Image size 1960x1897 — 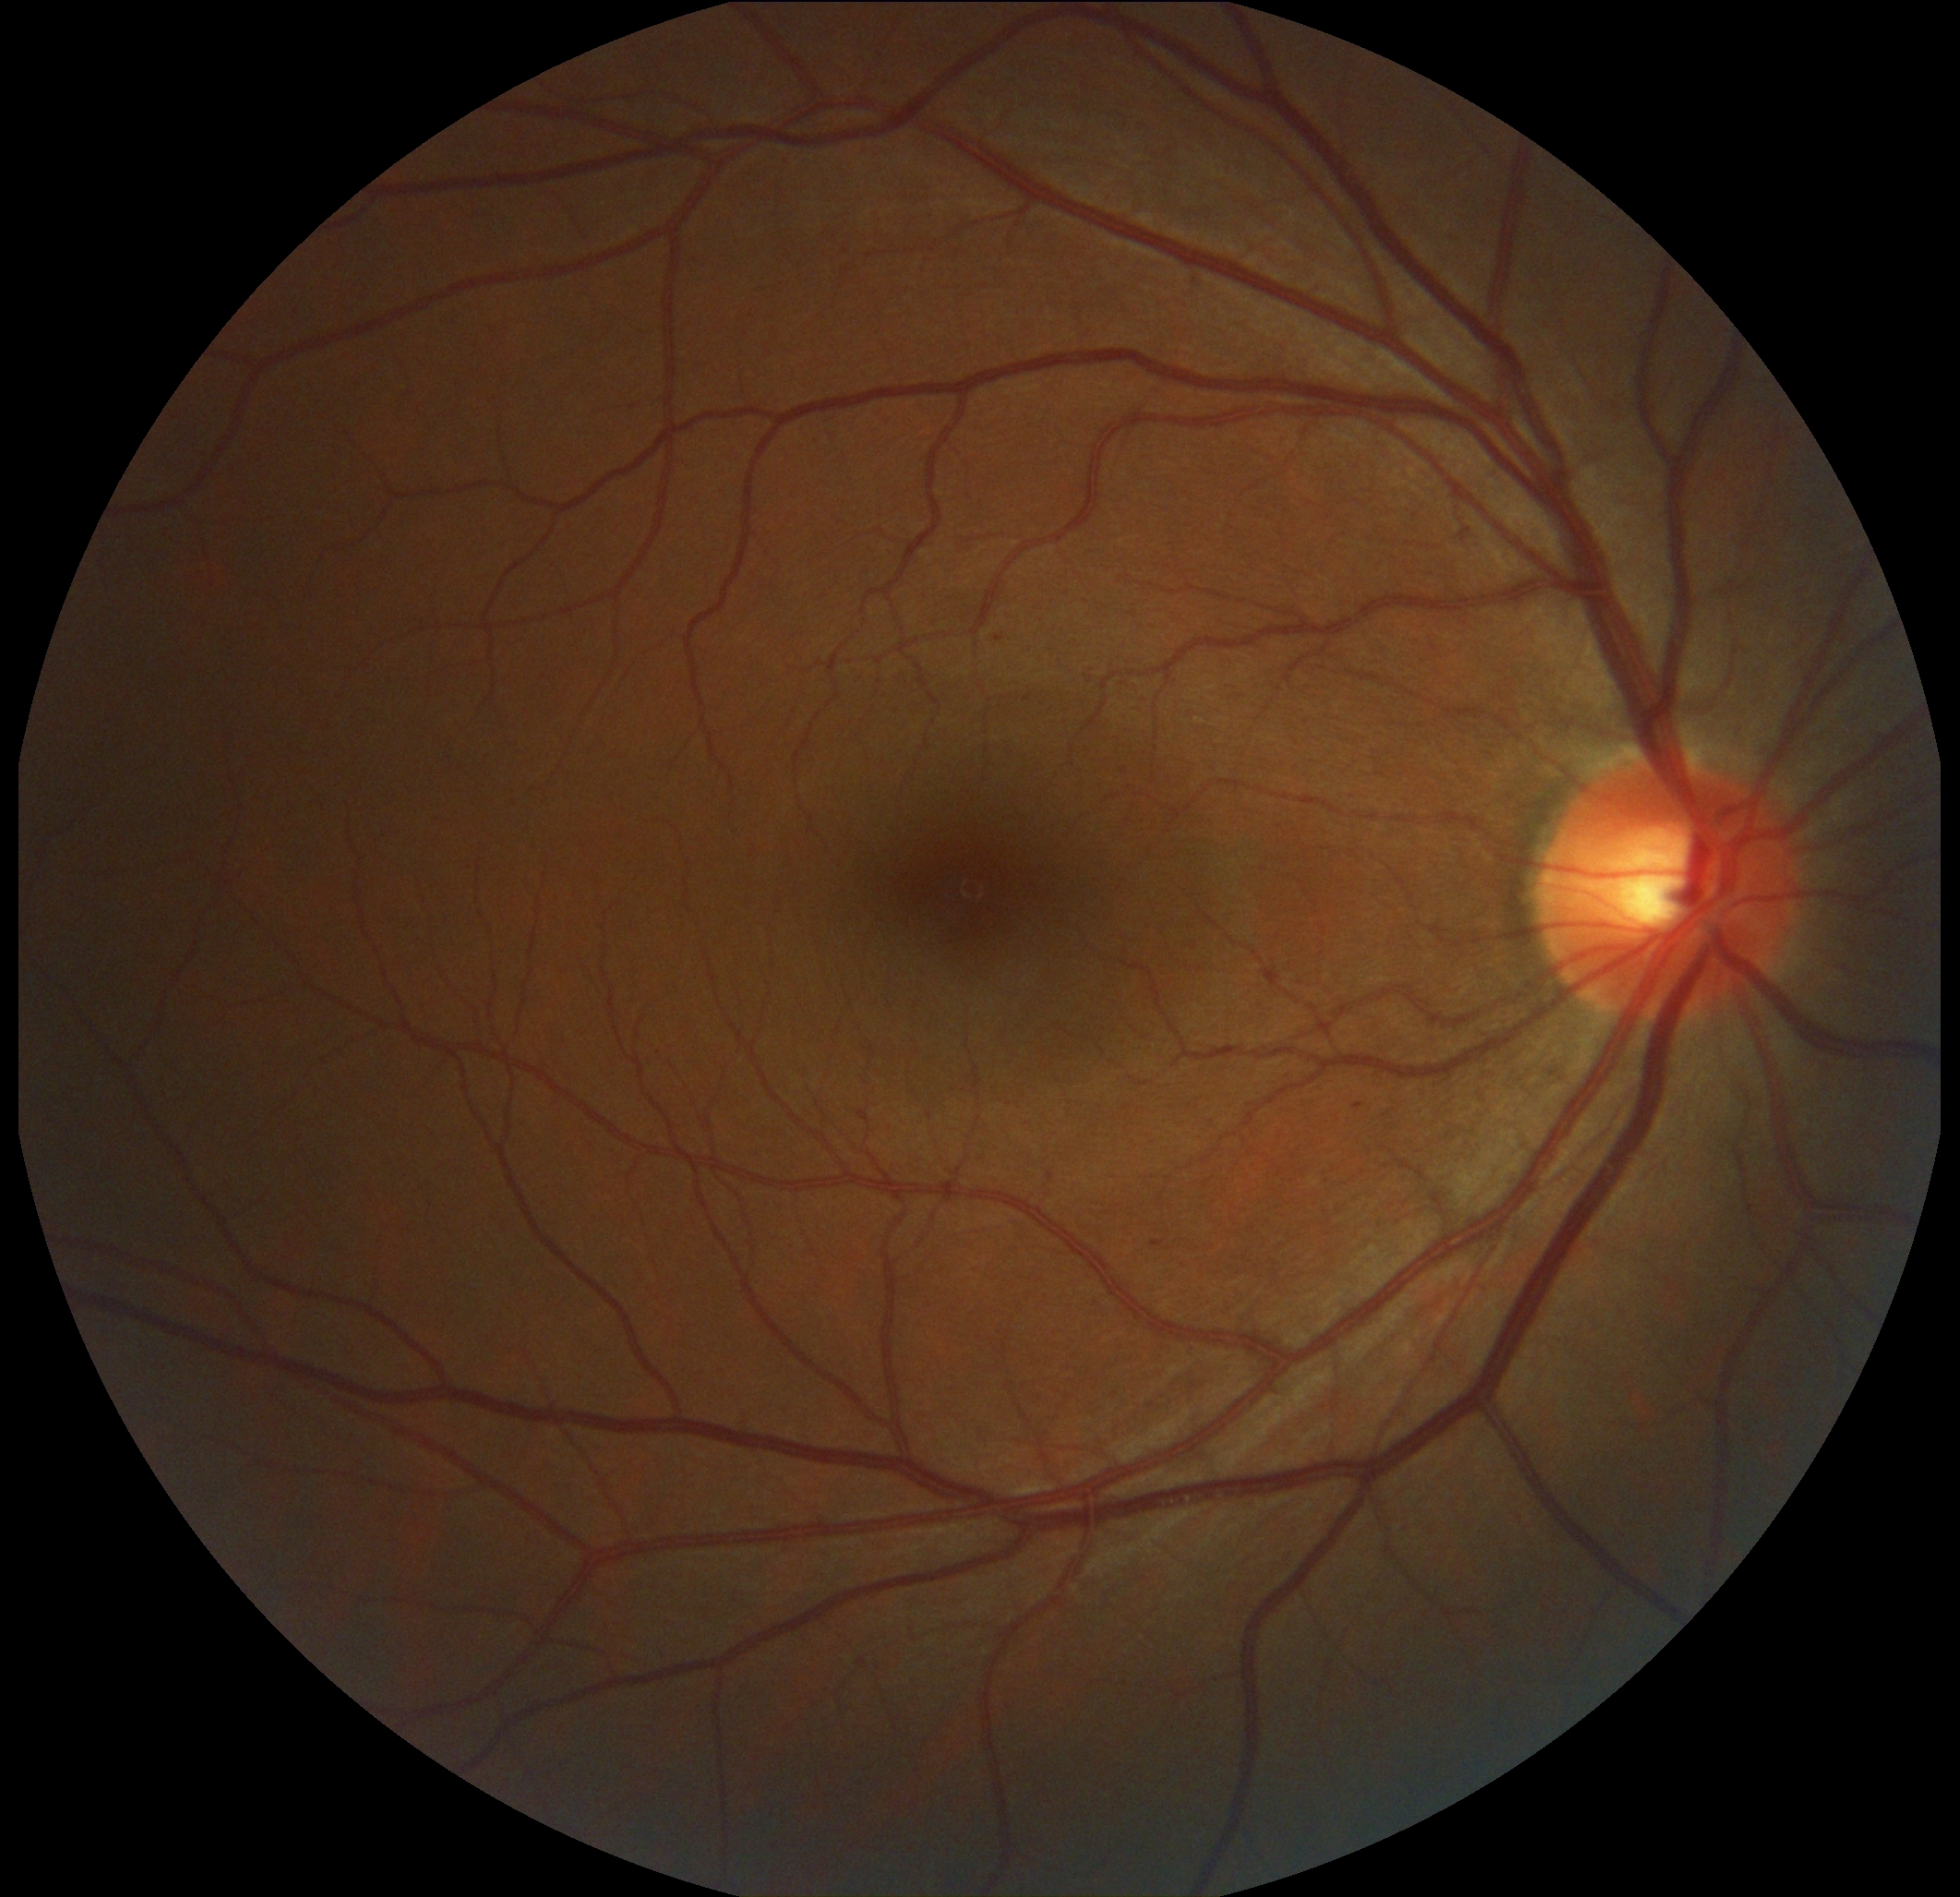 DR grade is mild NPDR (1) — presence of microaneurysms only
HEs: not present
MAs: <bbox>1152, 1241, 1166, 1248</bbox>; <bbox>1354, 1104, 1363, 1109</bbox>; <bbox>1048, 1173, 1054, 1181</bbox>; <bbox>1192, 279, 1204, 286</bbox>; <bbox>858, 1111, 872, 1125</bbox>
Small MAs approximately at <point>999, 639</point>
SEs: not present
EXs: not present